640 x 480 pixels · infant wide-field fundus photograph:
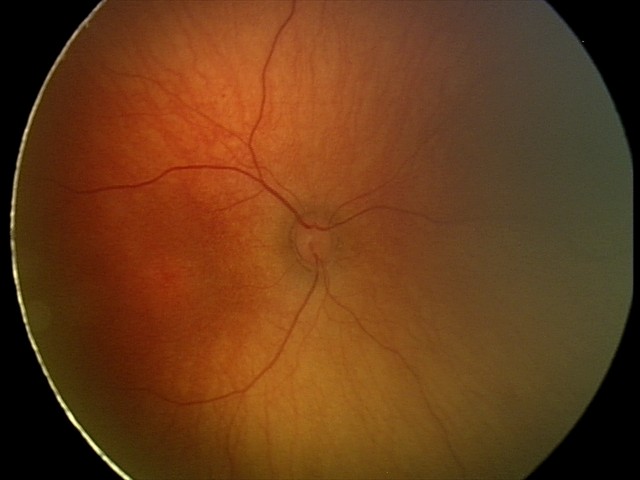

Screening examination with no abnormal retinal findings.